45° FOV · color fundus photograph · image size 2352x1568.
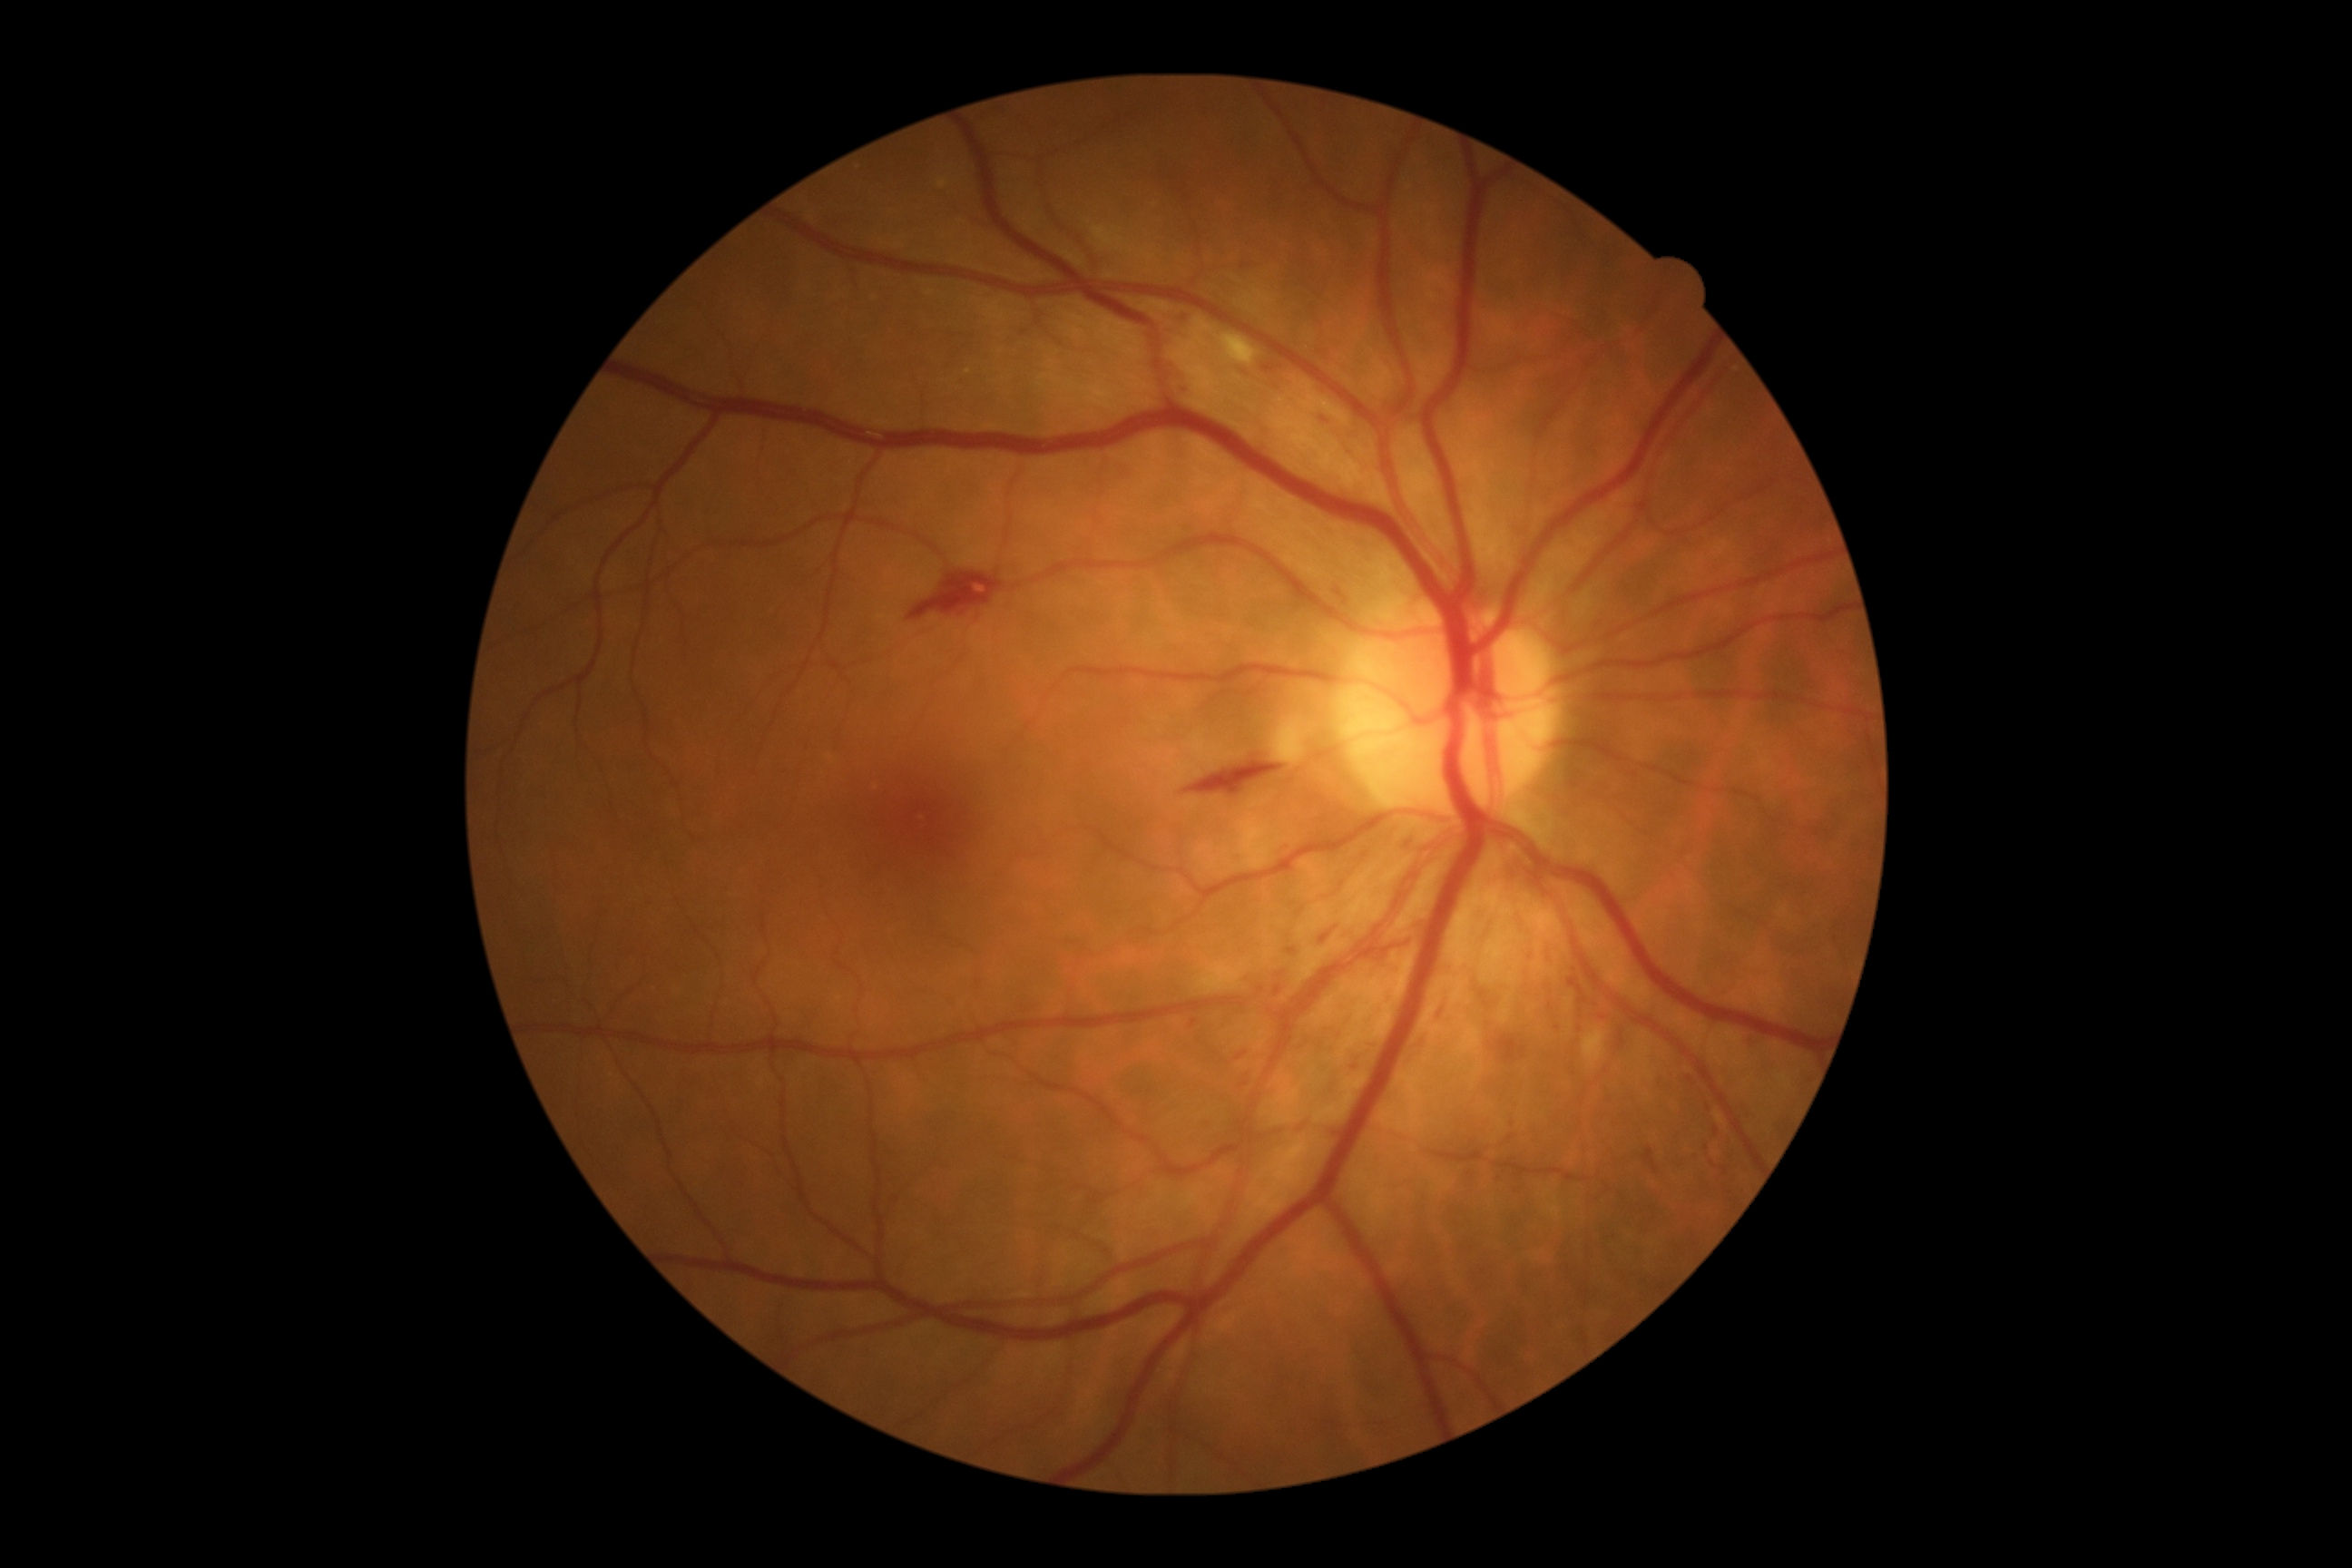

DR stage is grade 2 (moderate NPDR).
SEs are located at bbox=[1583, 1028, 1607, 1068]; bbox=[1277, 725, 1308, 763]; bbox=[1215, 335, 1259, 366].
MAs include bbox=[1206, 1124, 1215, 1133]; bbox=[1318, 415, 1333, 429]; bbox=[1750, 1041, 1758, 1046]; bbox=[1190, 1019, 1199, 1028]; bbox=[1182, 313, 1193, 328]; bbox=[1235, 1052, 1248, 1061]; bbox=[1184, 387, 1197, 397].
Smaller MAs around point(1690, 1080); point(1558, 1028); point(1551, 1007).
HEs are located at bbox=[1493, 1035, 1527, 1064]; bbox=[1404, 834, 1420, 848]; bbox=[1182, 760, 1284, 799]; bbox=[1337, 589, 1353, 607]; bbox=[1320, 932, 1331, 945]; bbox=[1569, 977, 1587, 1004]; bbox=[1643, 1148, 1660, 1175]; bbox=[1475, 981, 1496, 1008]; bbox=[1351, 1063, 1362, 1072]; bbox=[906, 573, 1003, 622]; bbox=[1422, 1032, 1427, 1043]; bbox=[1242, 1070, 1257, 1086]; bbox=[1435, 999, 1447, 1023].
Smaller HEs around point(1291, 951).
No EXs identified.